Wide-field retinal mosaic image — 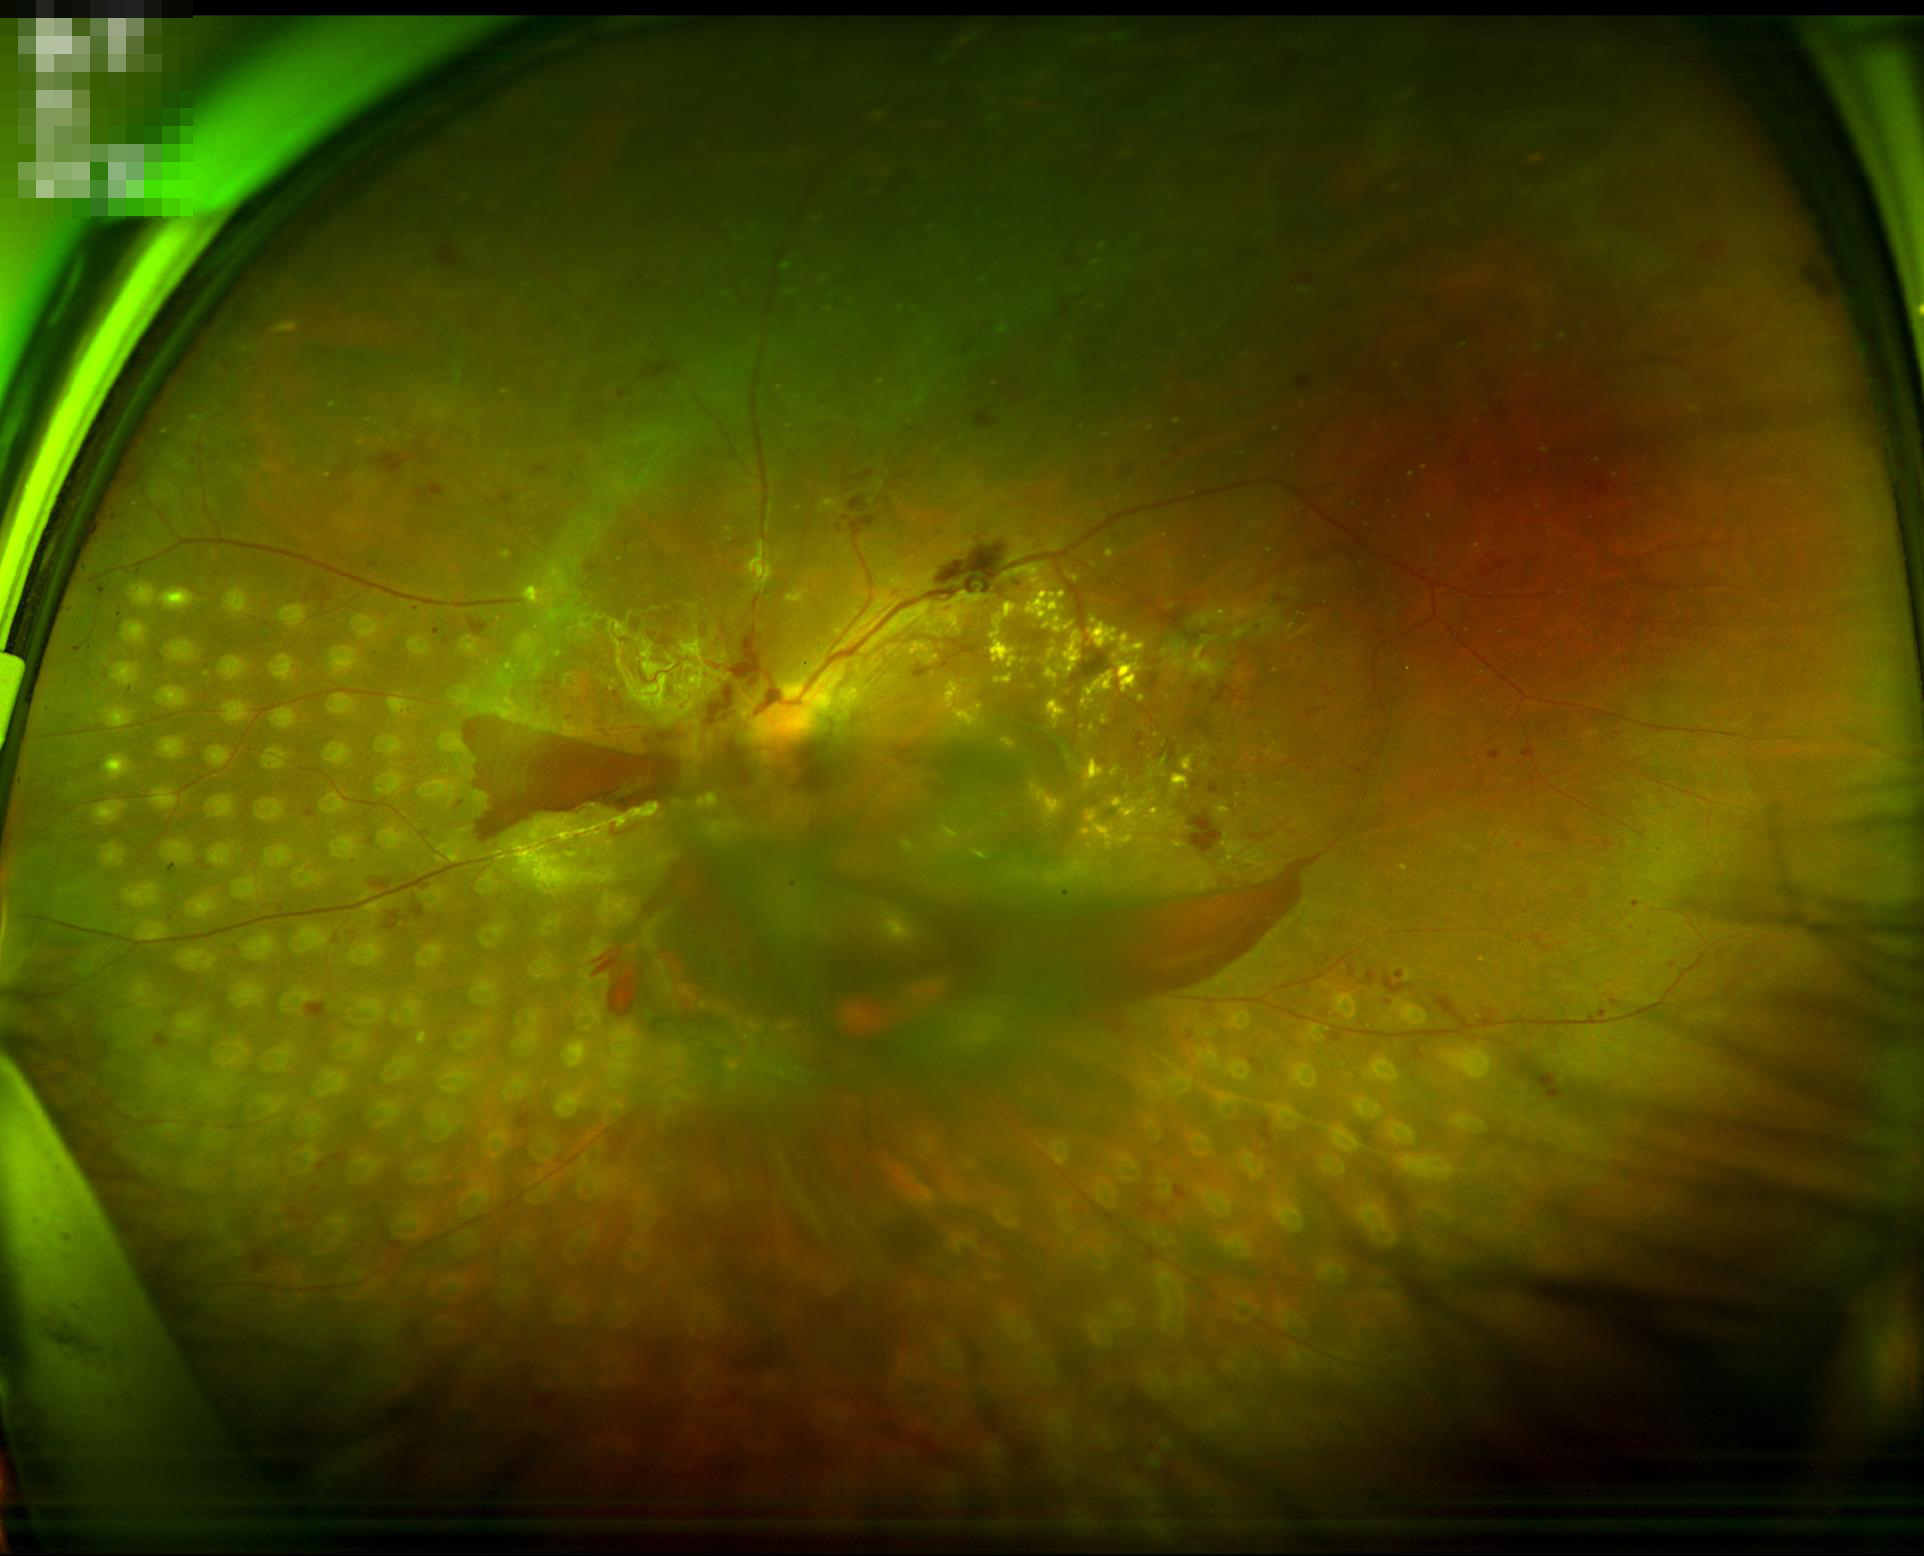

Illumination = even | Overall image quality = inadequate | Focus = poor | Contrast = adequate.